Image size 2346x1568. FOV: 45 degrees:
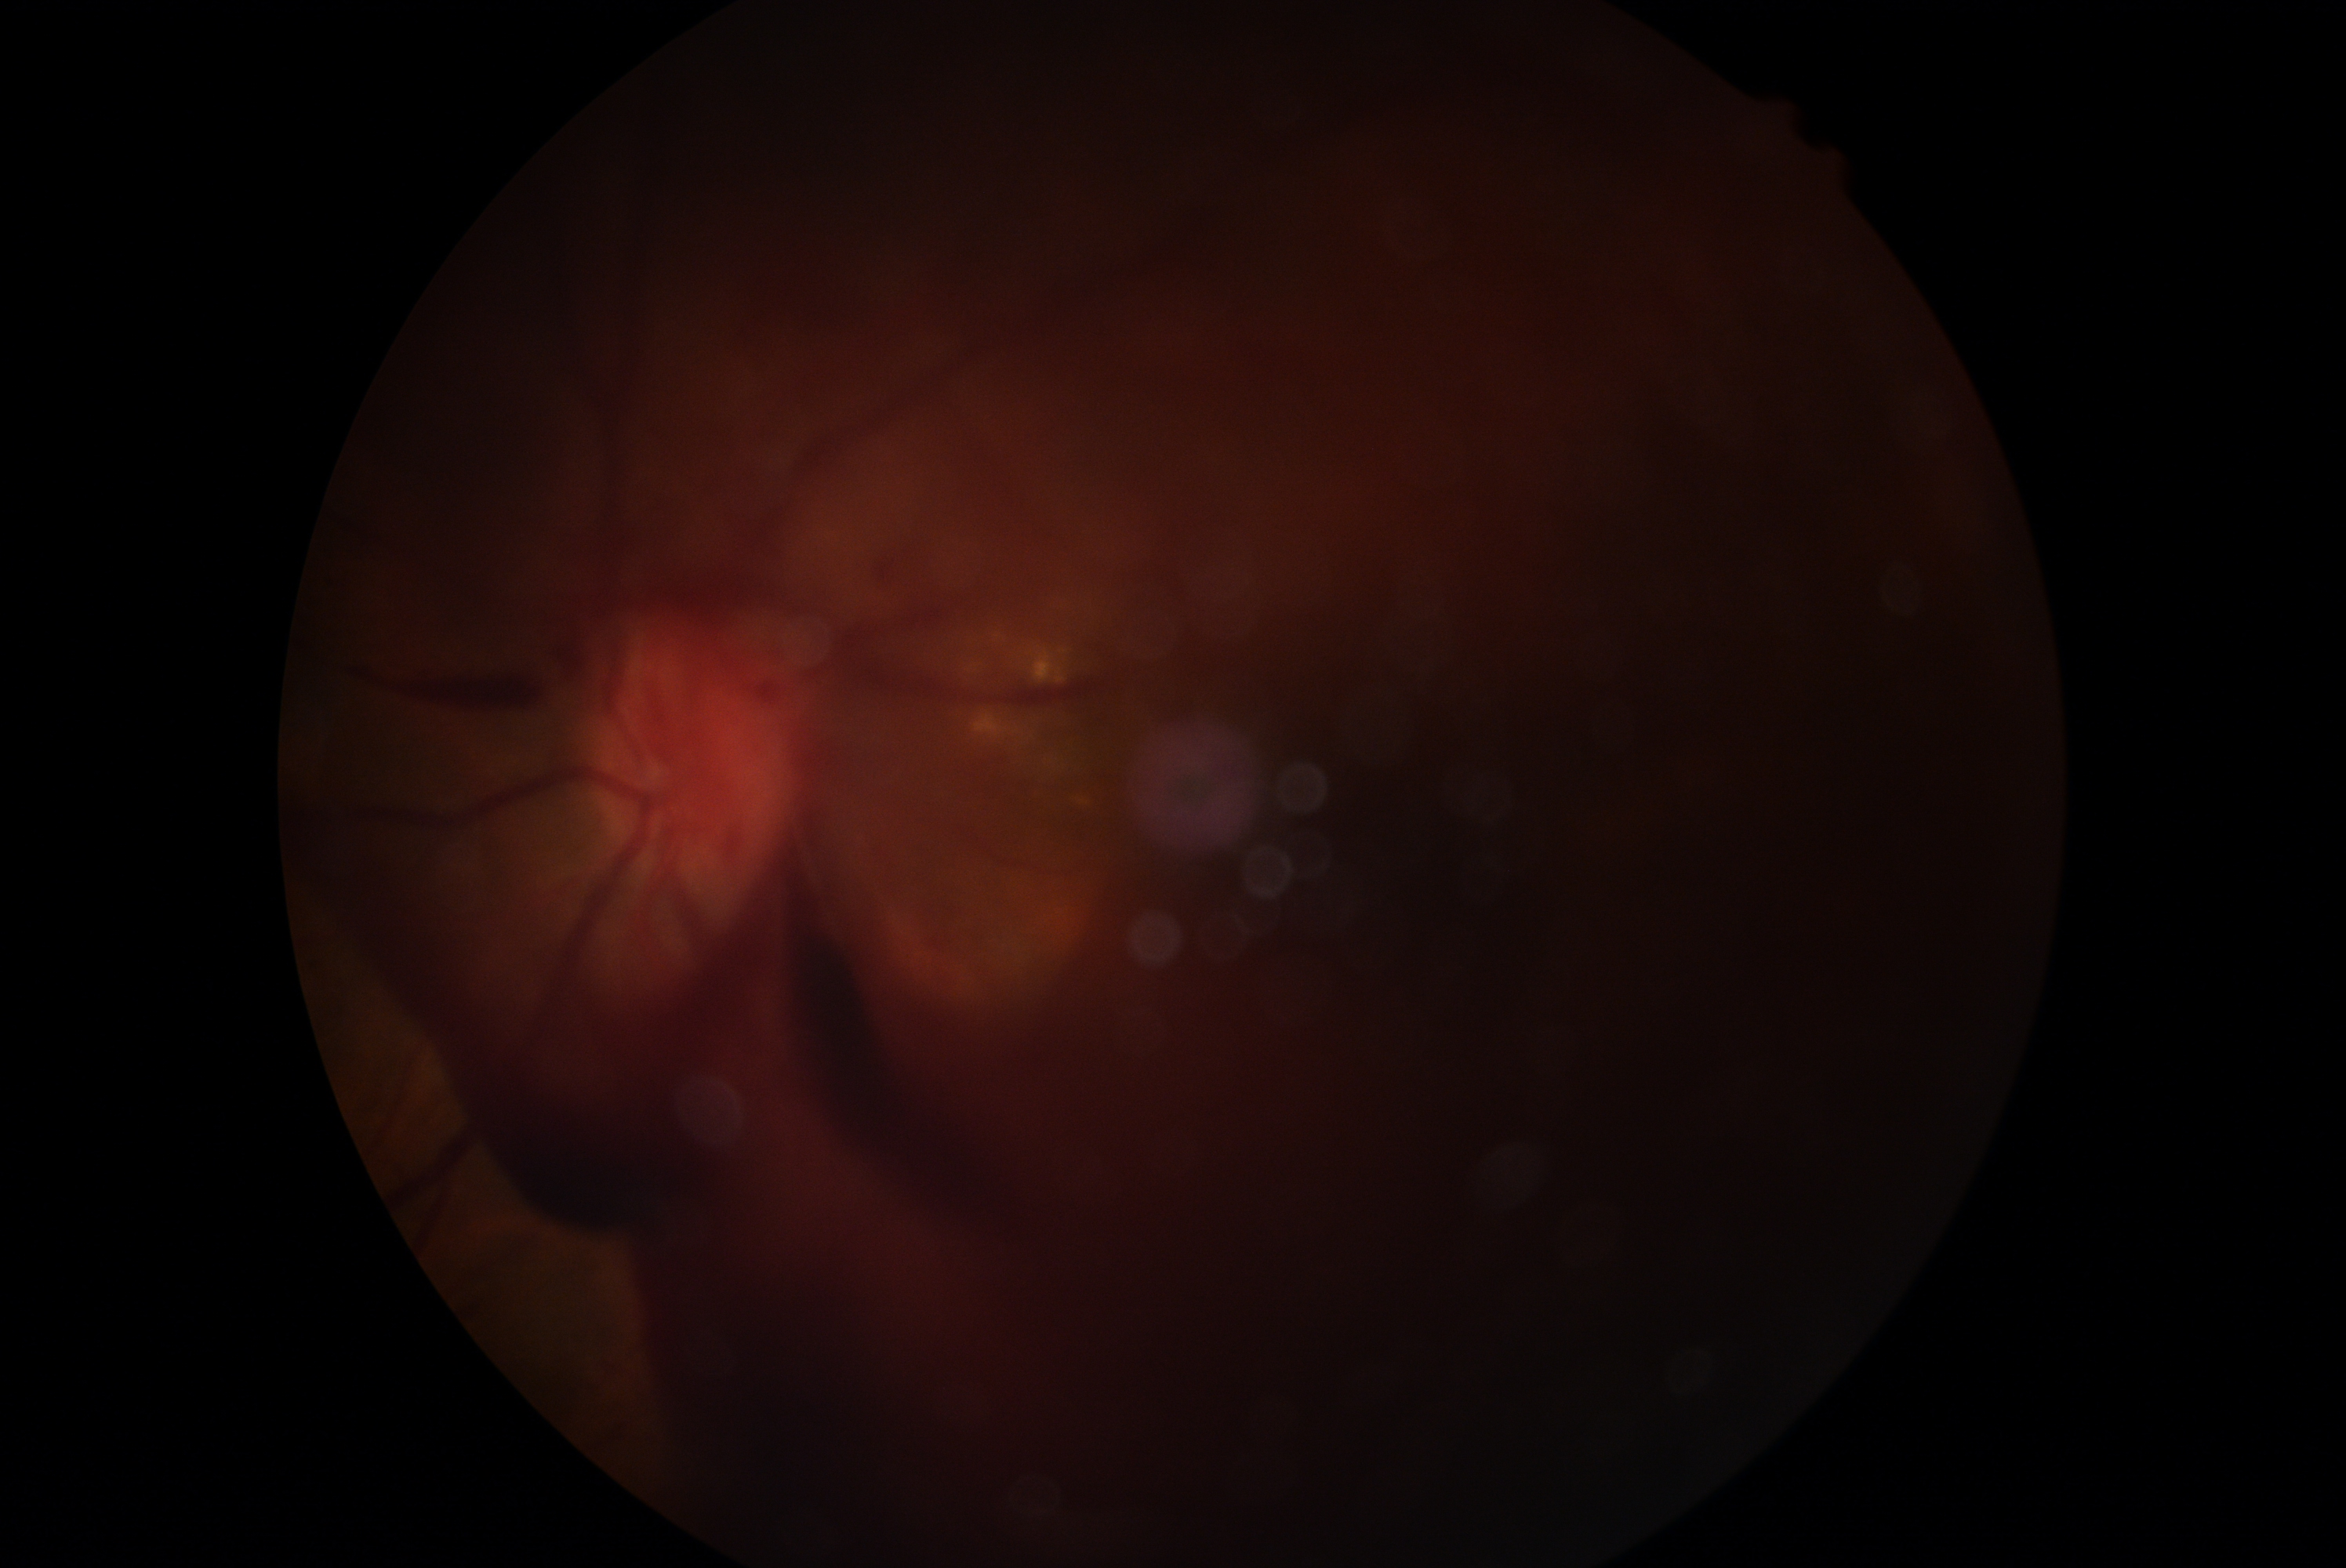
Retinopathy: PDR (grade 4).